Infant wide-field retinal image
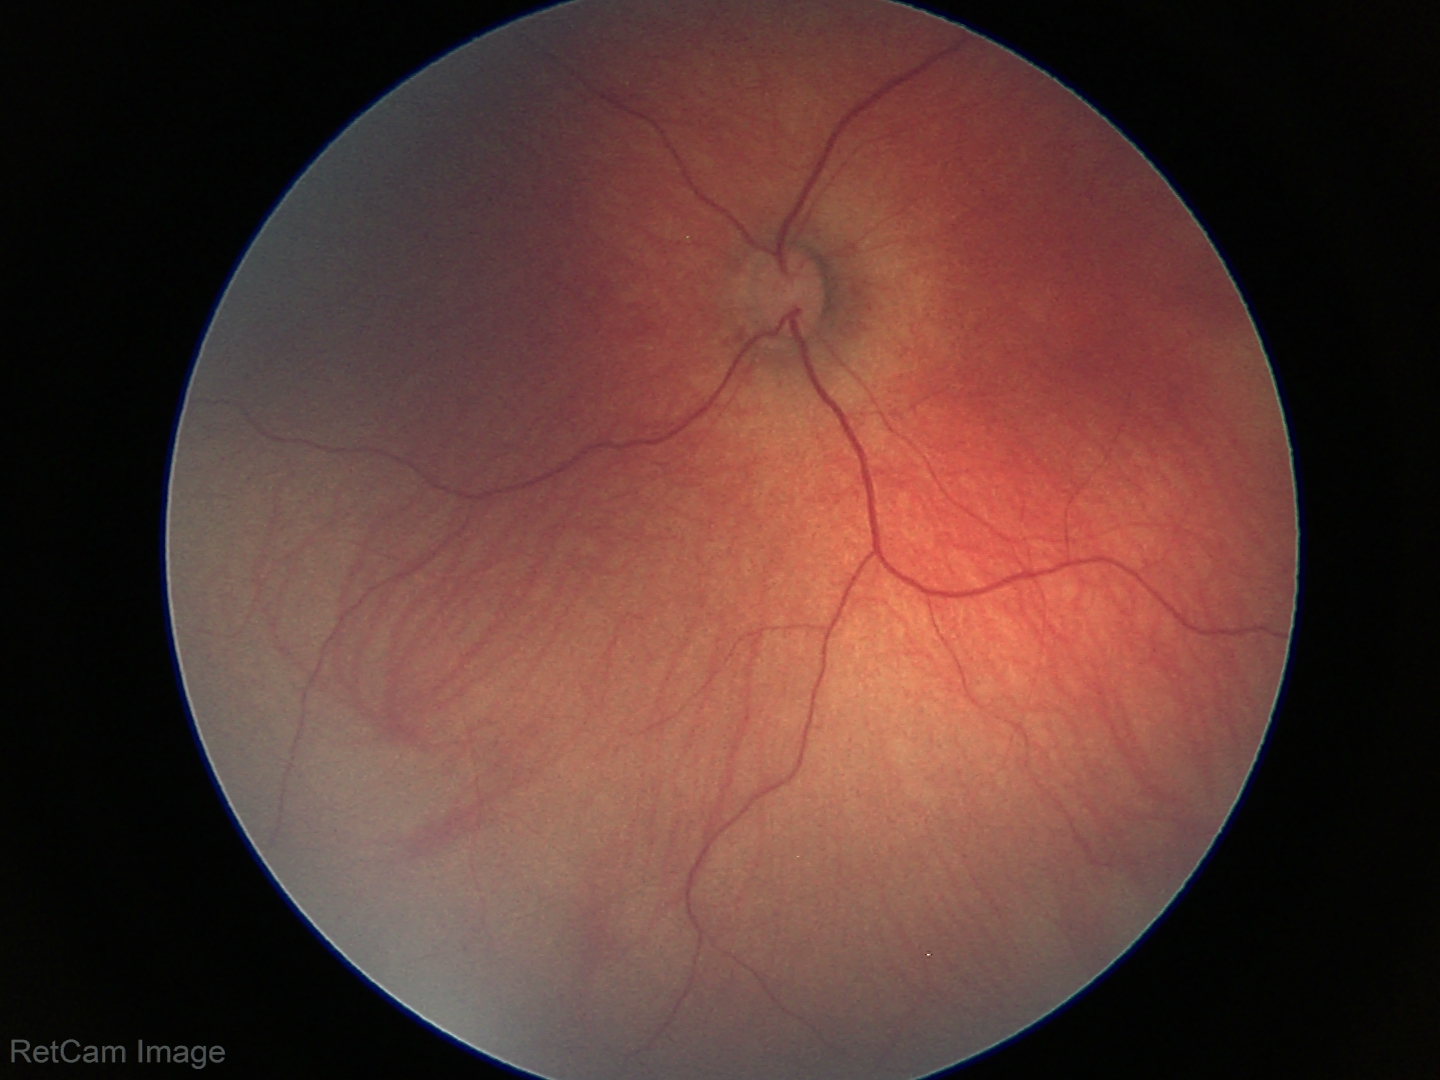
Normal screening examination.